1240x1240px. Wide-field contact fundus photograph of an infant:
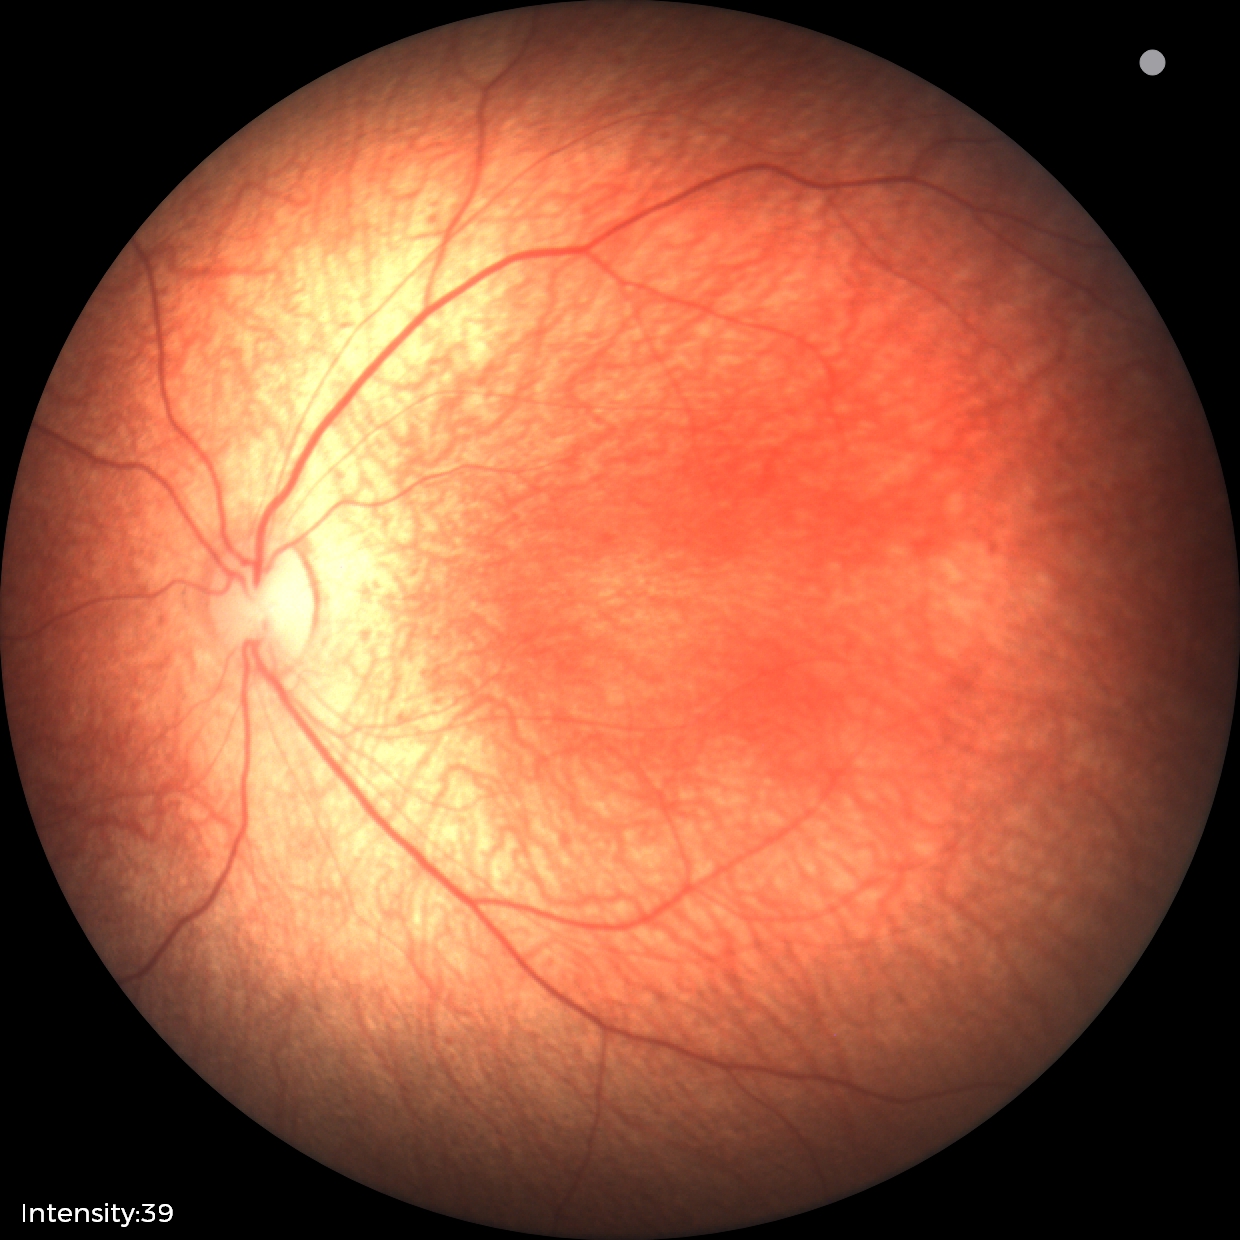

Screening examination with no abnormal retinal findings.